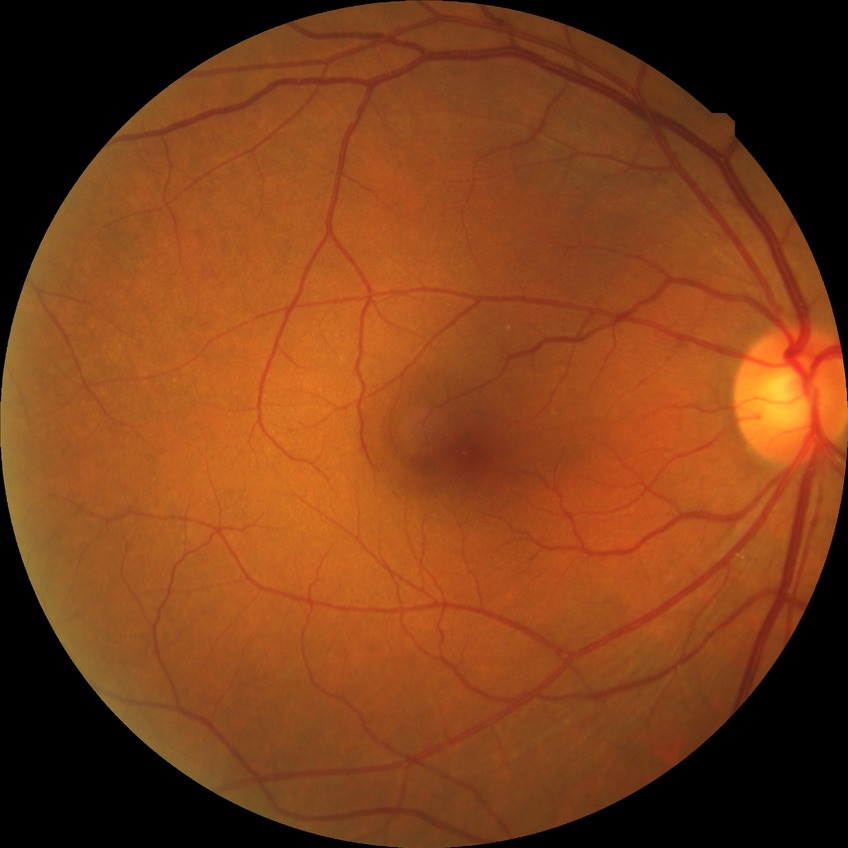

diabetic retinopathy (DR)@NDR (no diabetic retinopathy).